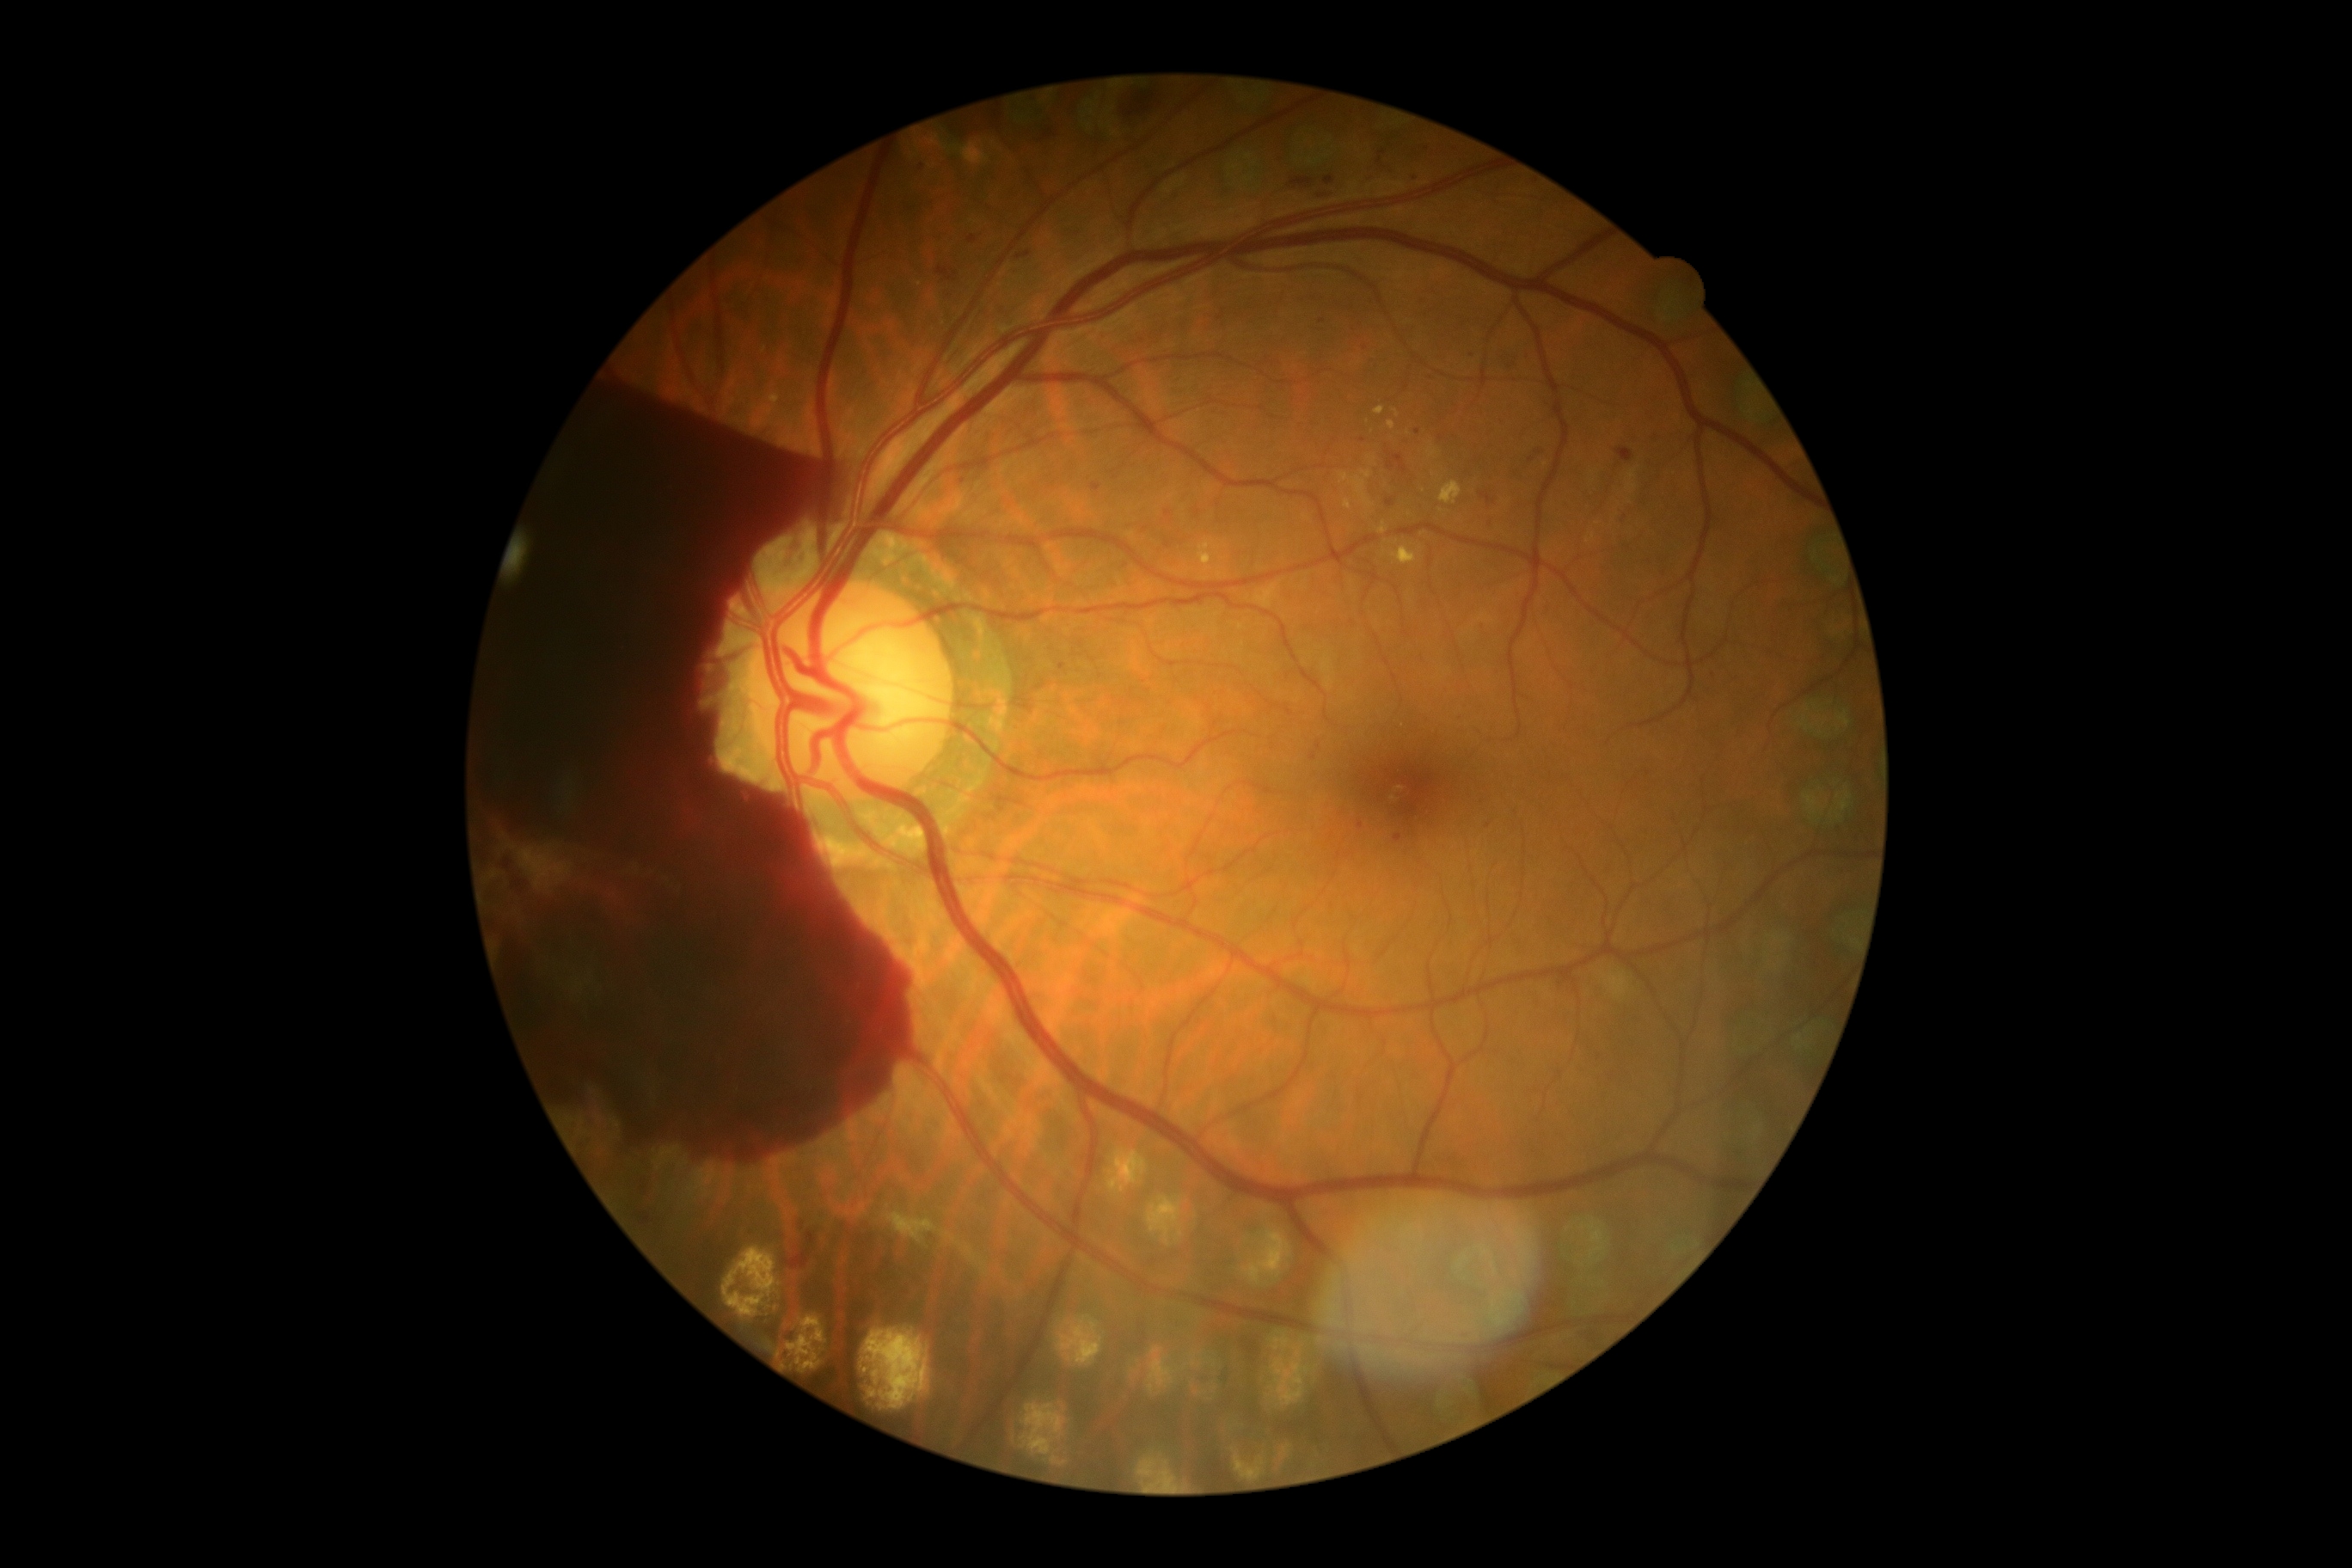
{
  "dr_grade": "PDR (grade 4)"
}